512x512; CFP:
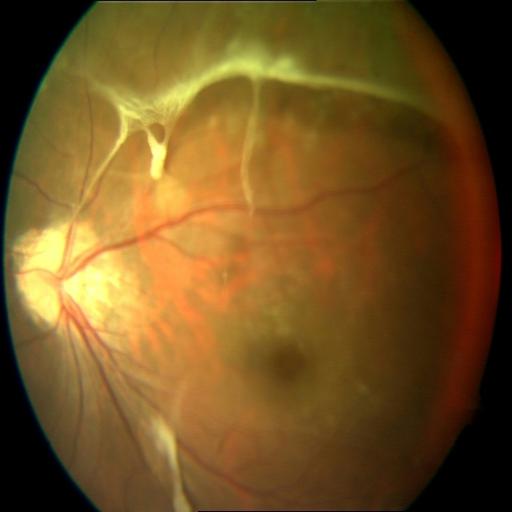

Findings consistent with retinal traction (RT).